50-degree field of view, color fundus image, centered on the macula
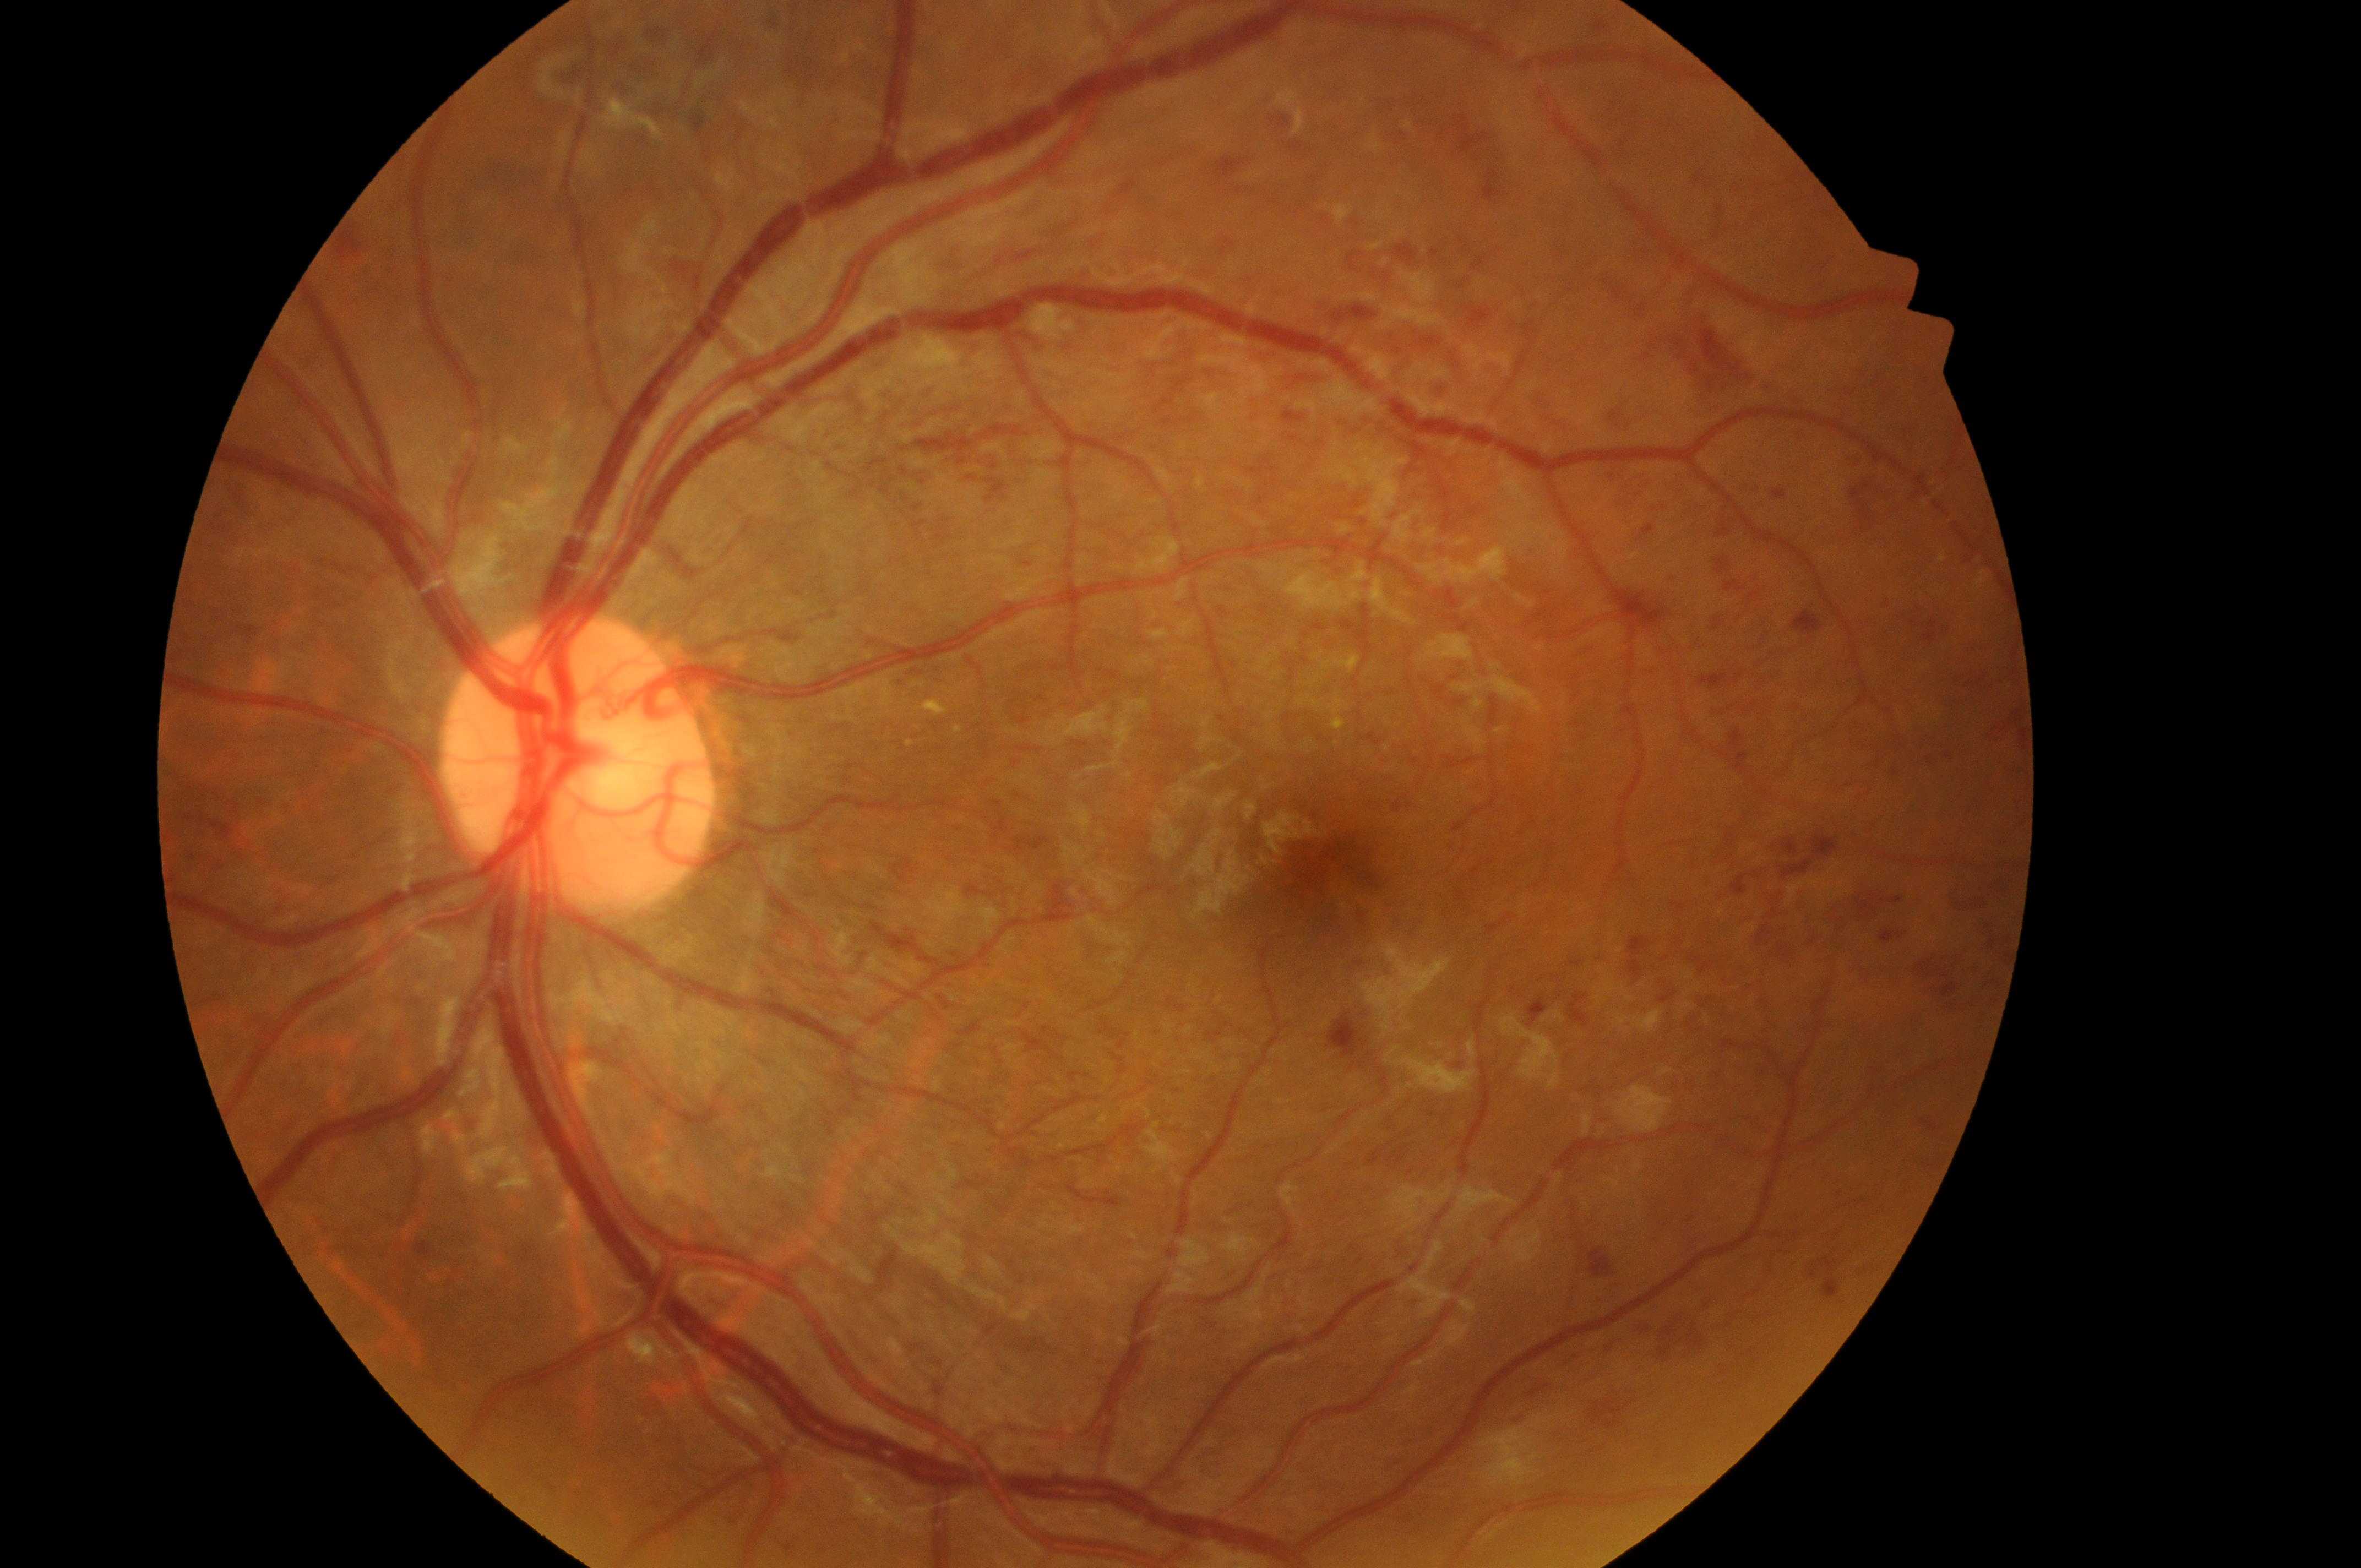

Optic disc center: 573px, 775px.
Macular center: 1330px, 880px.
DR: grade 4.
This is the left eye.
DME grade is 2.